Optic disc-centered crop from a color fundus photograph:
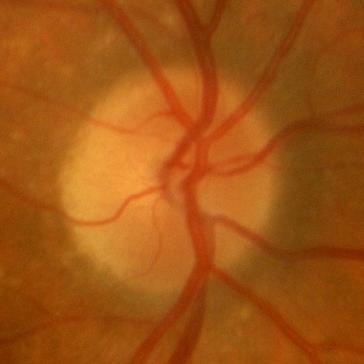

Glaucoma assessment = no glaucomatous damage.